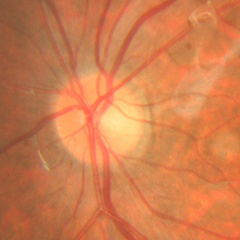

Findings consistent with no signs of glaucoma.